No pharmacologic dilation.
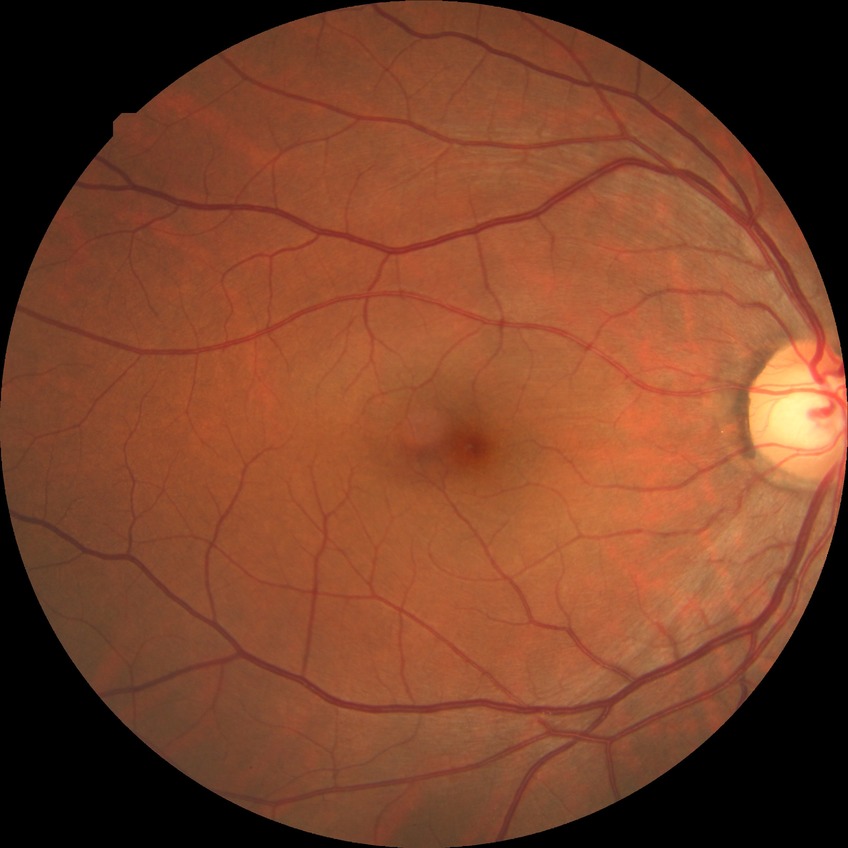

Assessment:
* diabetic retinopathy stage — no diabetic retinopathy